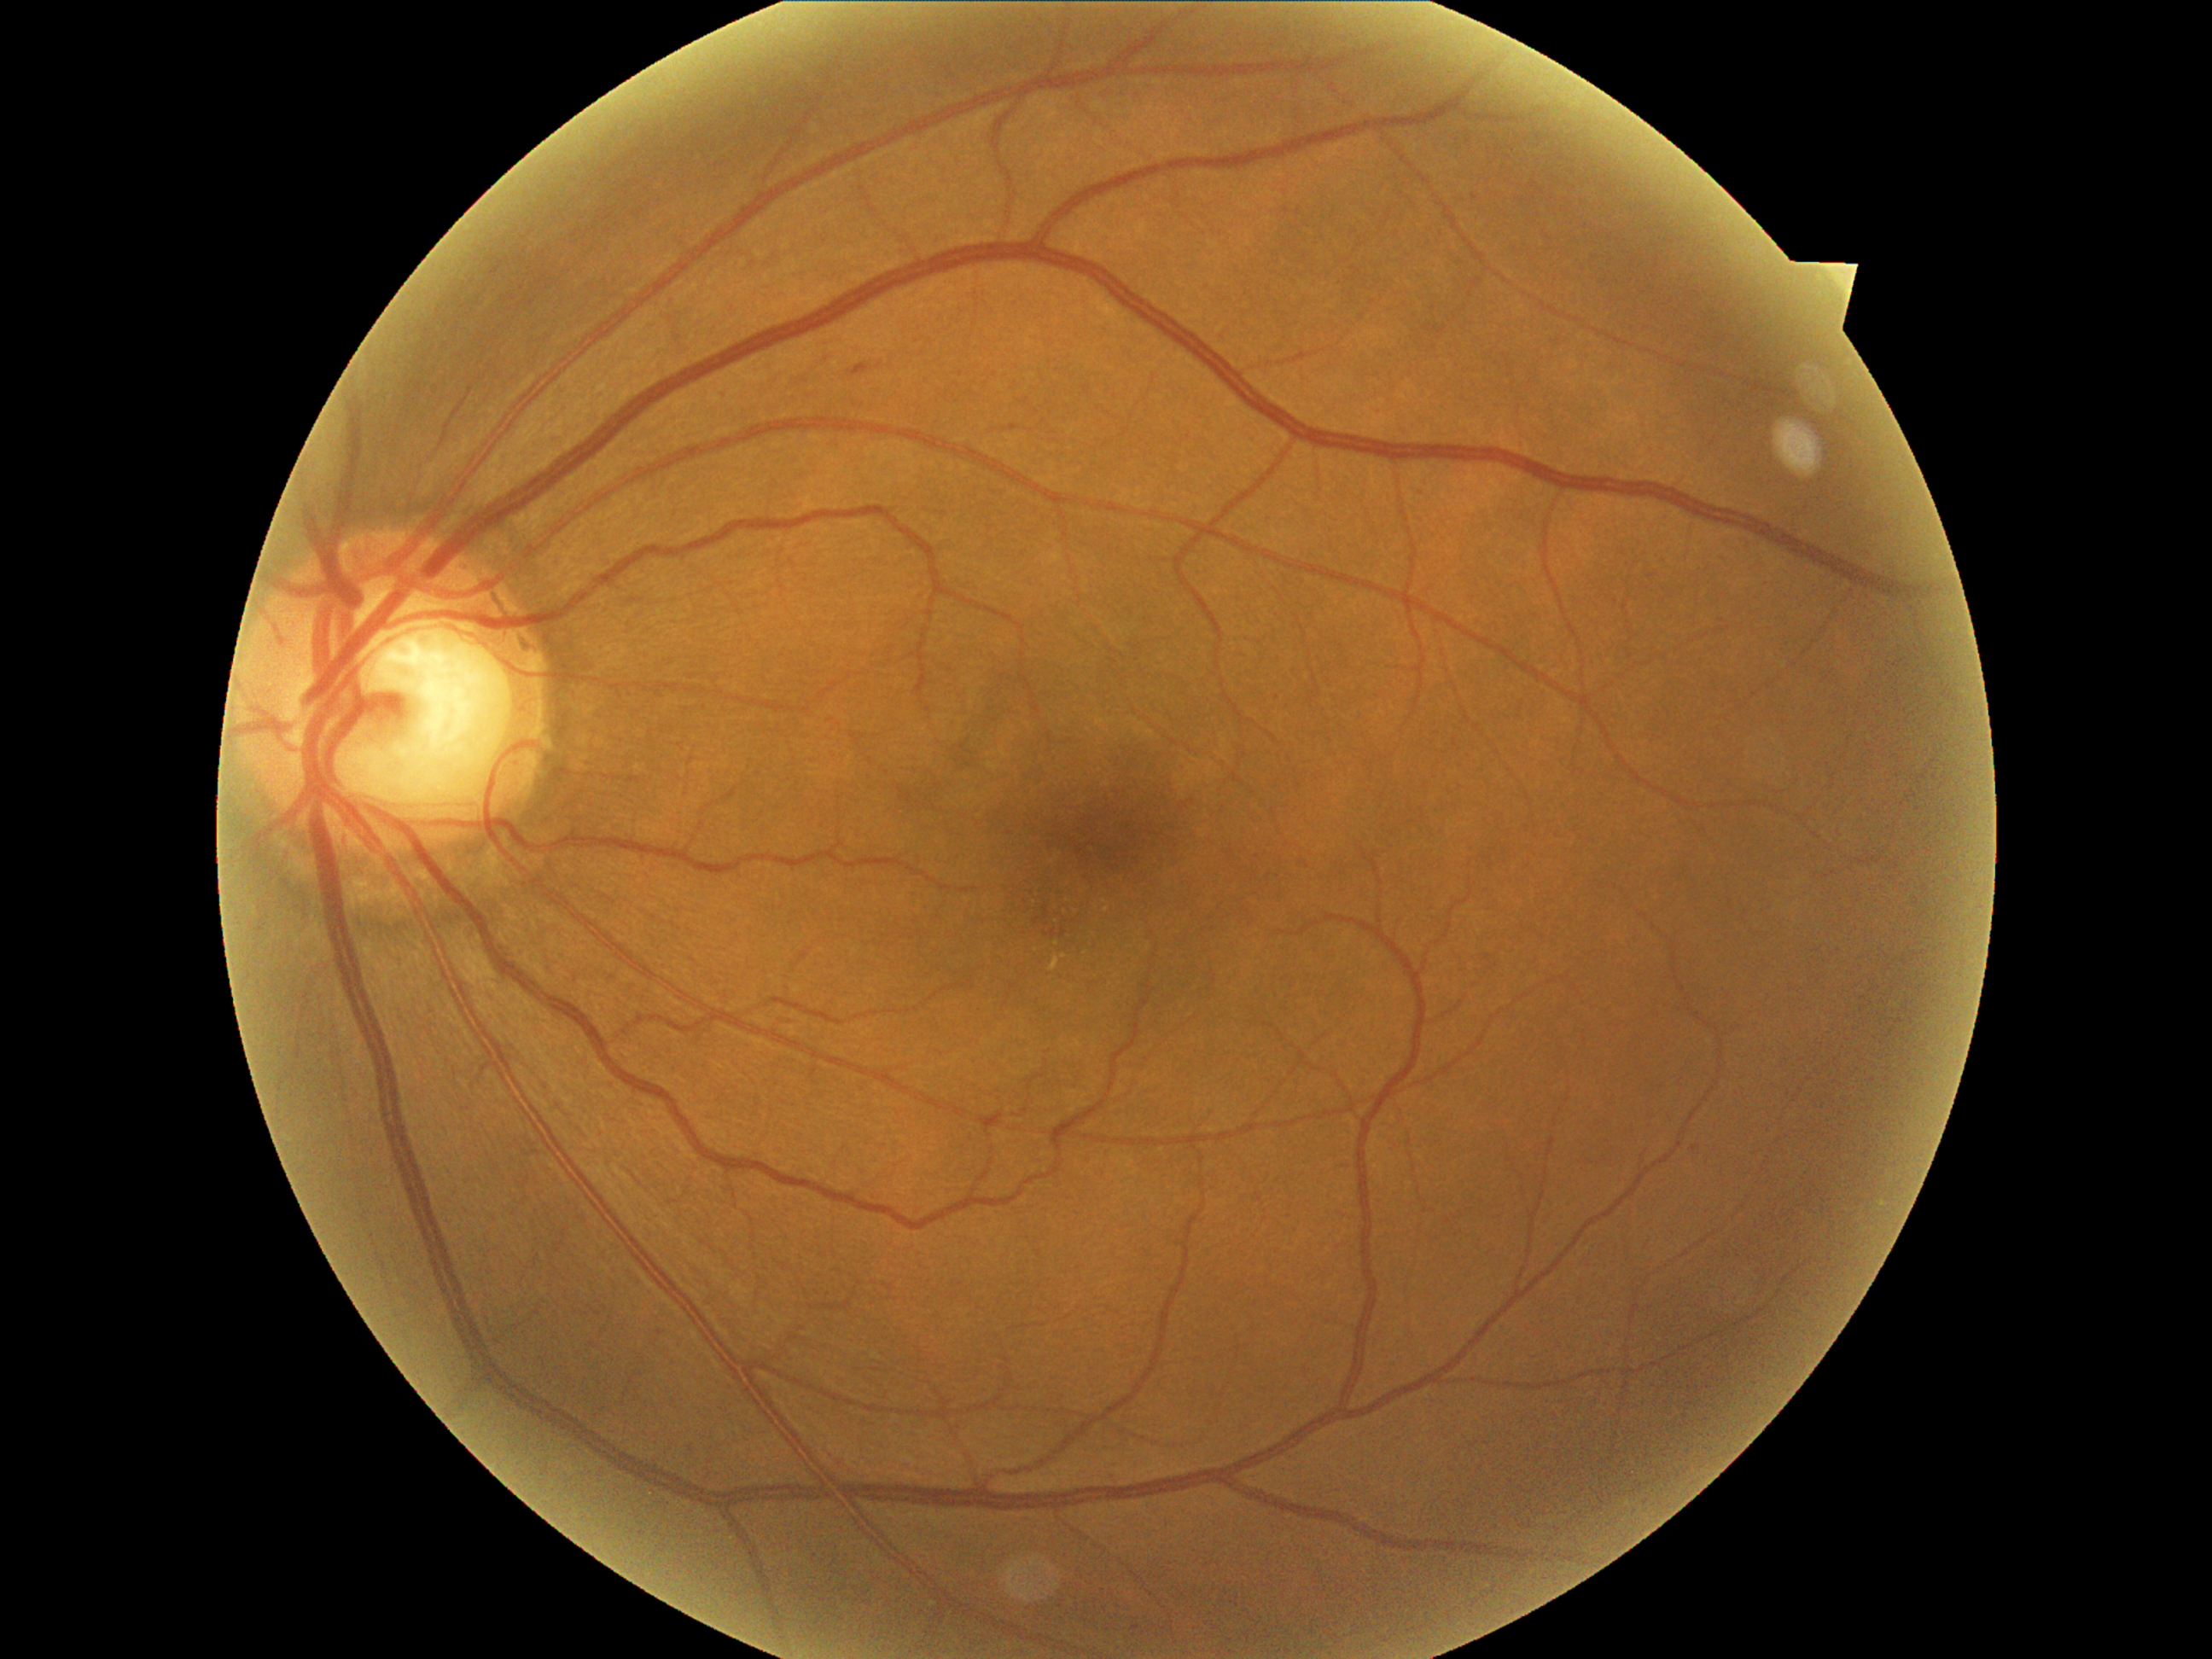

Diabetic retinopathy (DR) is grade 2 (moderate NPDR)
Representative lesions:
soft exudates (SEs) = absent
hard exudates (EXs) = [x1=1051, y1=957, x2=1061, y2=972]
Small EXs near x=1105, y=902, x=1086, y=953, x=1037, y=950, x=1065, y=956, x=1107, y=909
hemorrhages (HEs) (partial) = [x1=849, y1=364, x2=870, y2=376], [x1=1044, y1=929, x2=1057, y2=938], [x1=1061, y1=928, x2=1066, y2=938], [x1=1044, y1=905, x2=1051, y2=921]
Small HEs near x=1036, y=920
microaneurysms (MAs) = [x1=1484, y1=955, x2=1493, y2=962]
Small MAs near x=1694, y=1149